640x480; RetCam wide-field infant fundus image: 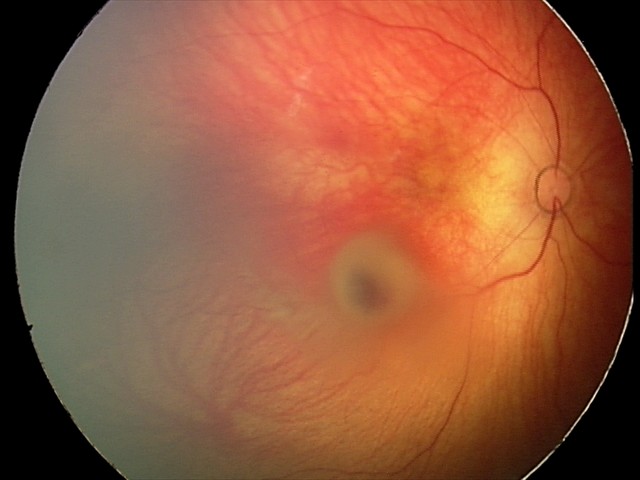

Q: What was the screening finding?
A: retinal hemorrhages